Retinal fundus photograph · 848 x 848 pixels · DR severity per modified Davis staging · camera: NIDEK AFC-230 · no pharmacologic dilation · 45 degree fundus photograph.
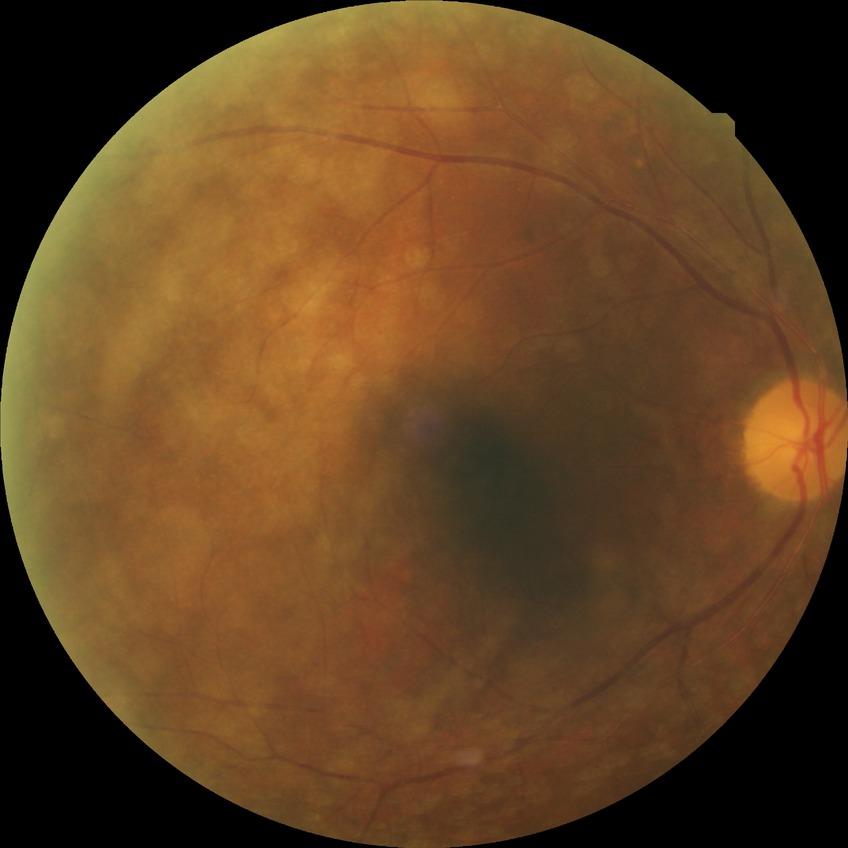 No DR findings. DR is NDR.